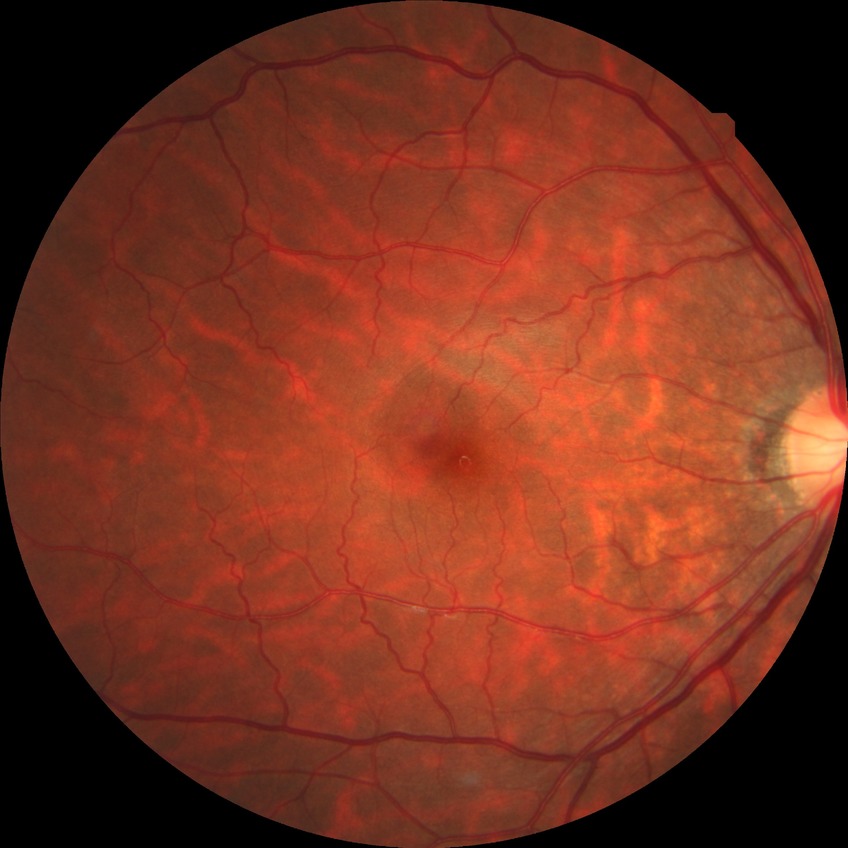 Davis grading: no diabetic retinopathy.